1932 x 1932 pixels; captured after pupil dilation; retinal fundus photograph — 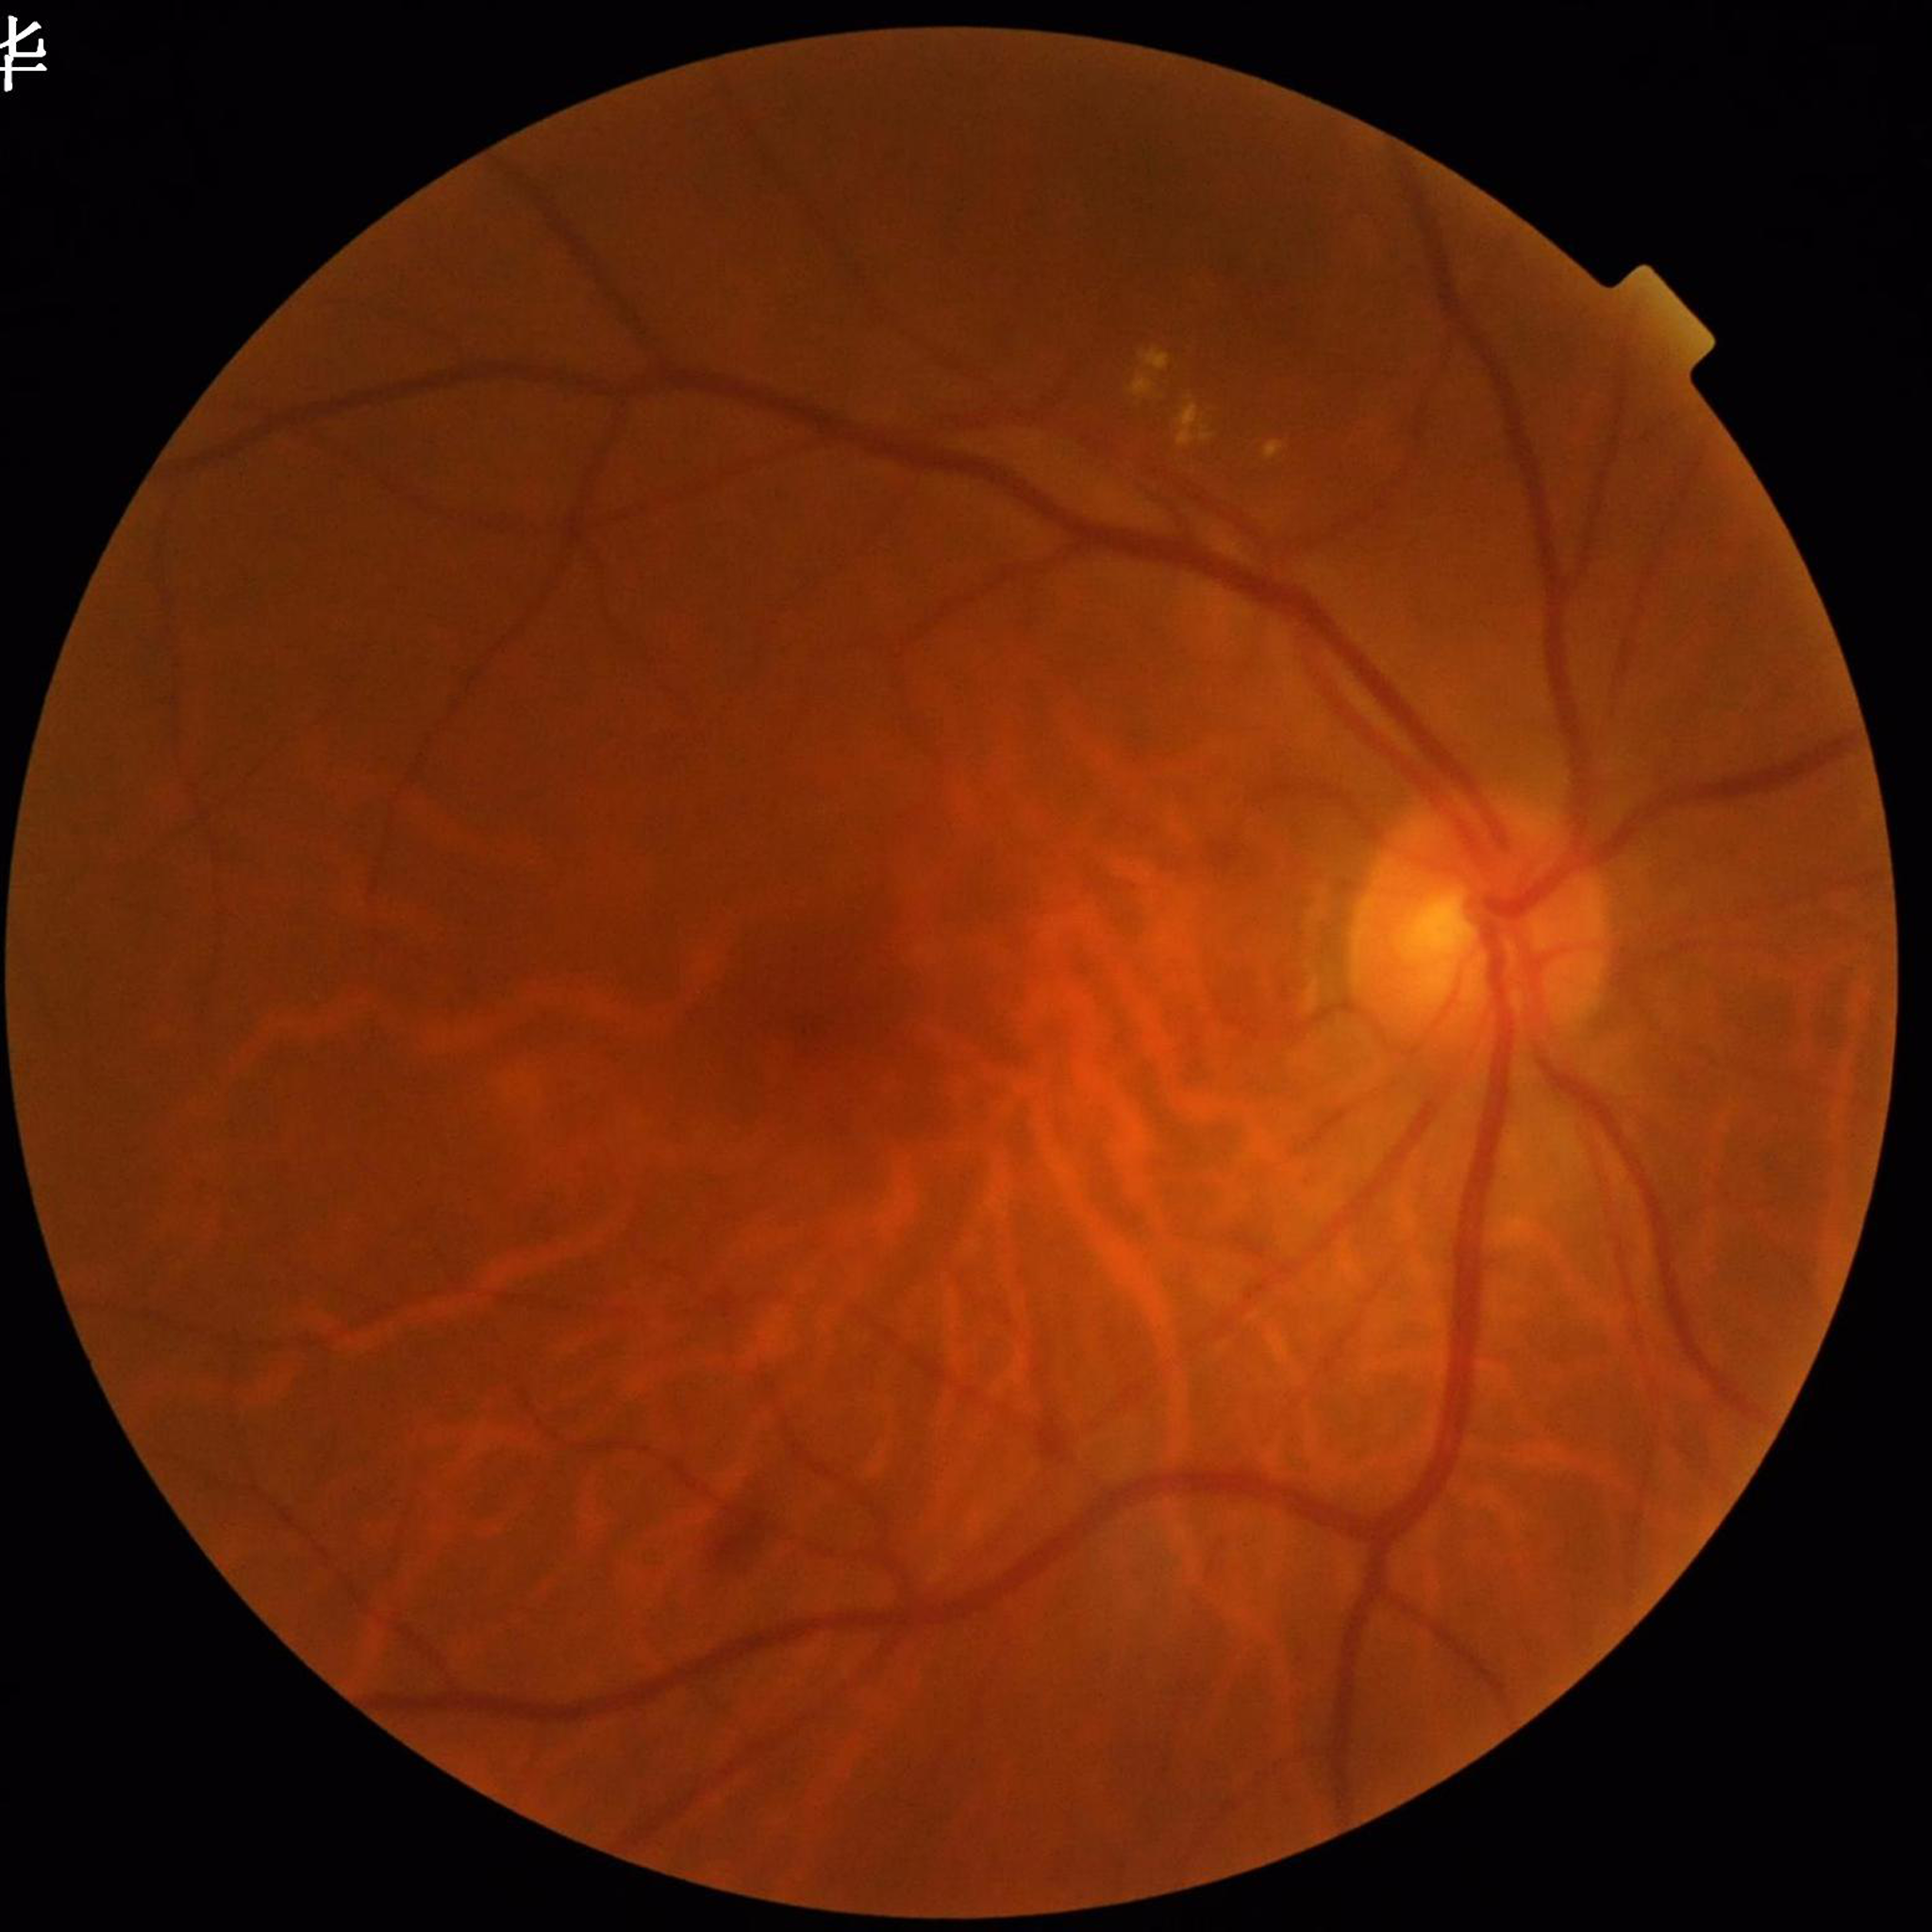

image_quality: satisfactory
diagnosis: DR